Color fundus photograph
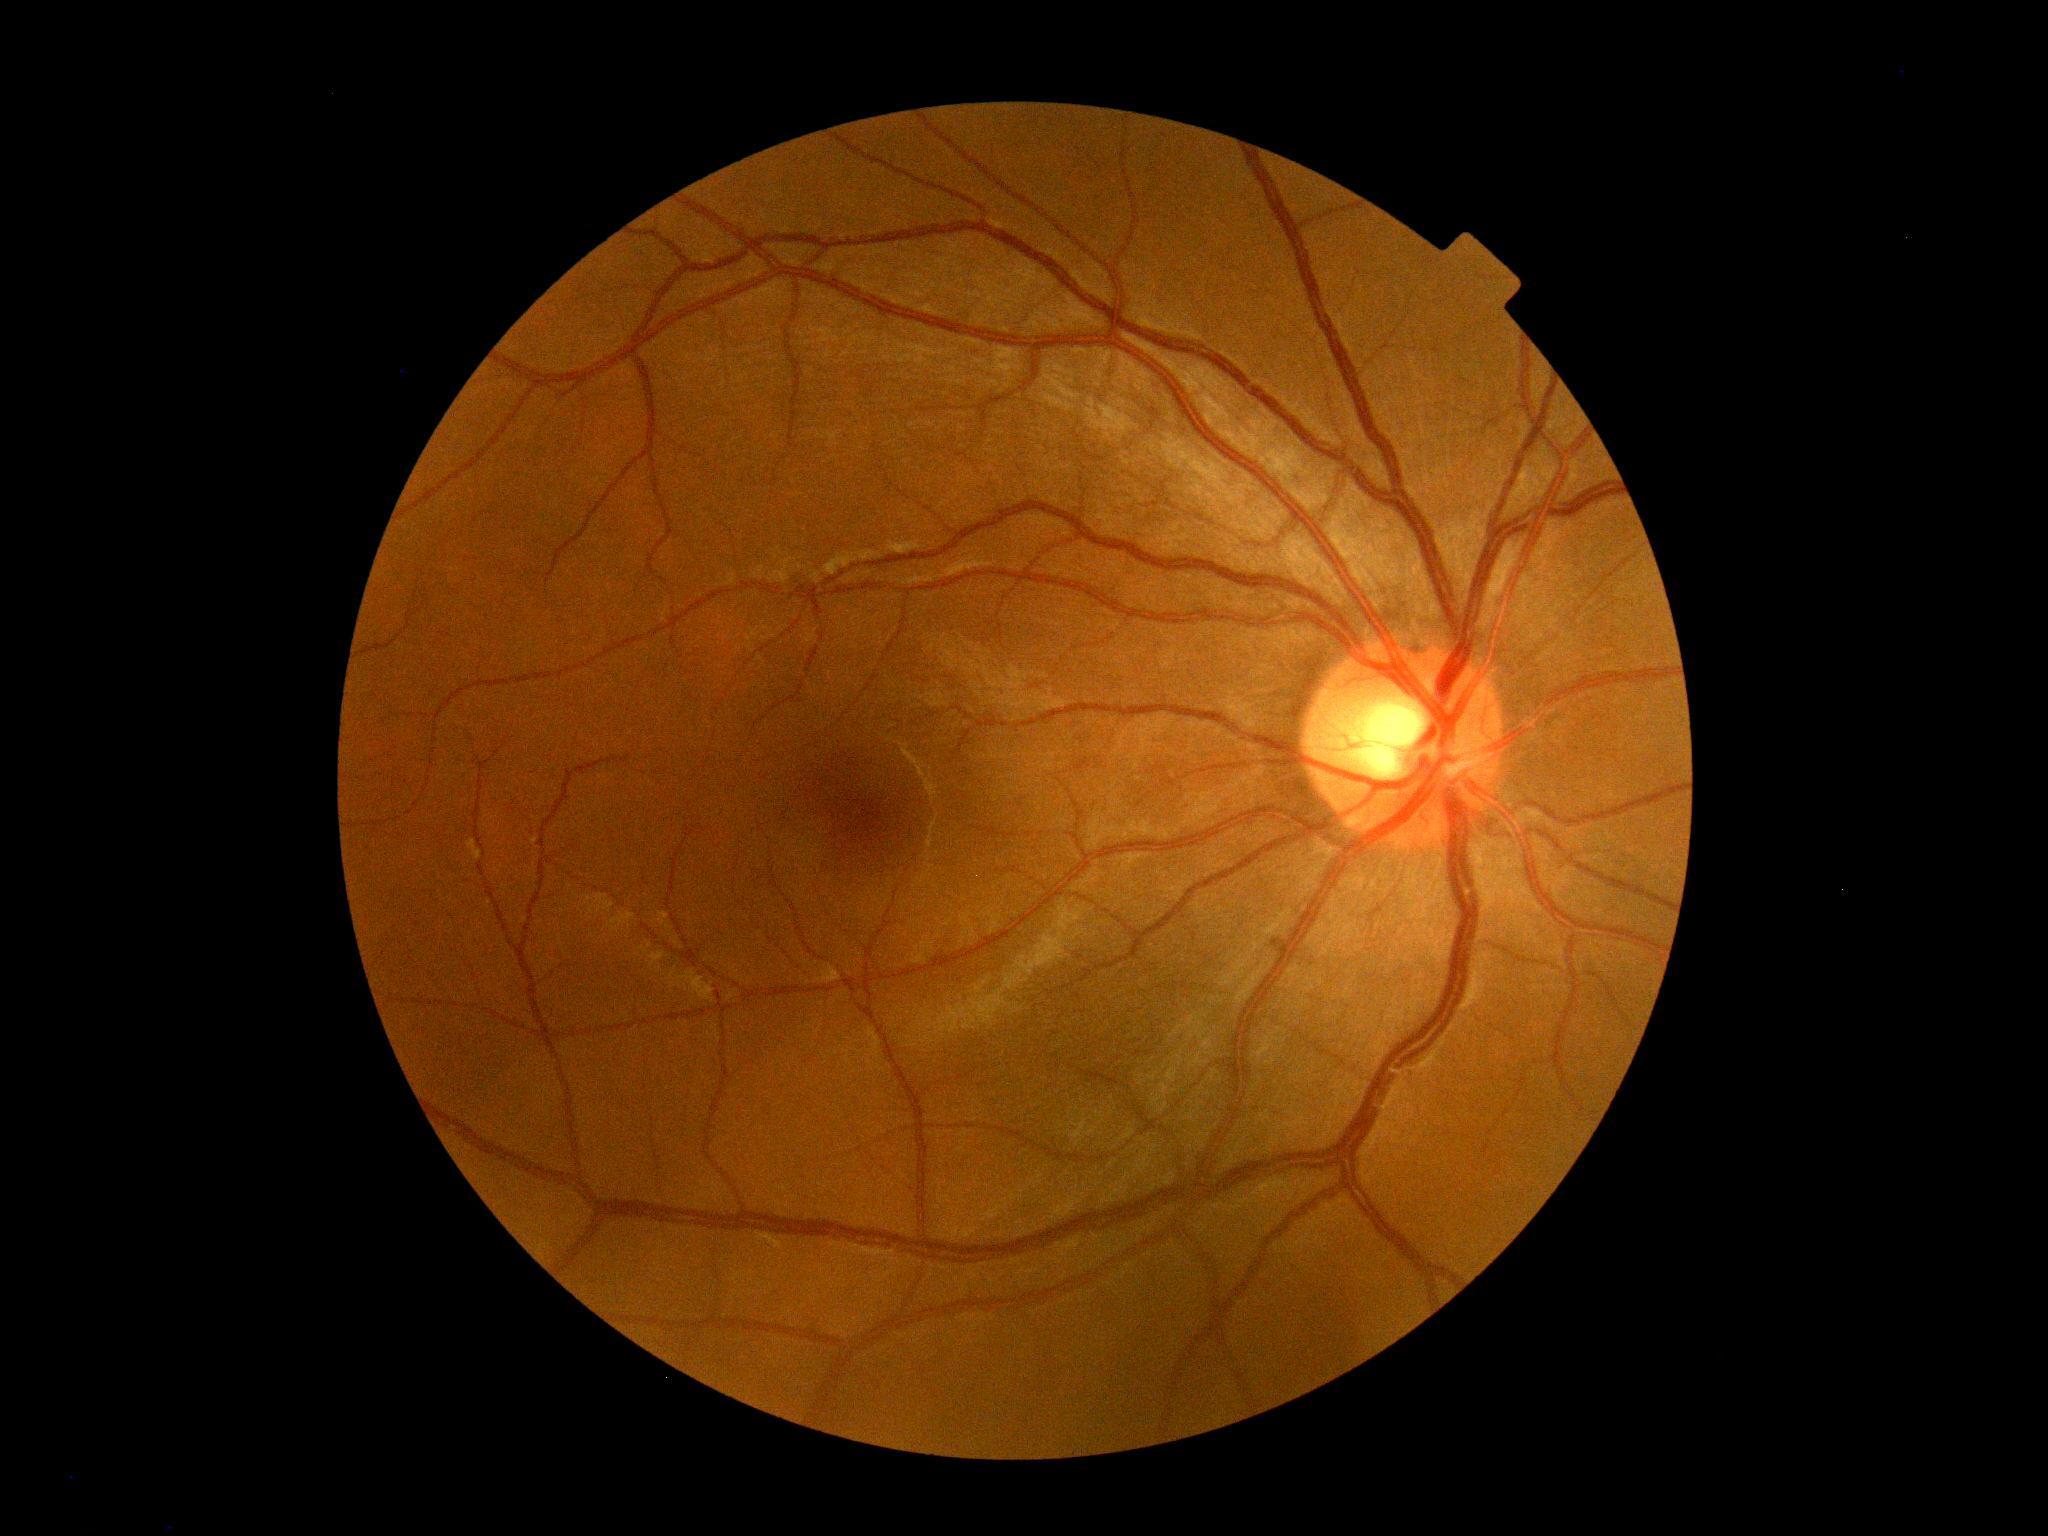
diabetic retinopathy (DR): no apparent retinopathy (grade 0)